Infant wide-field fundus photograph · Phoenix ICON, 100° FOV · 1240x1240px — 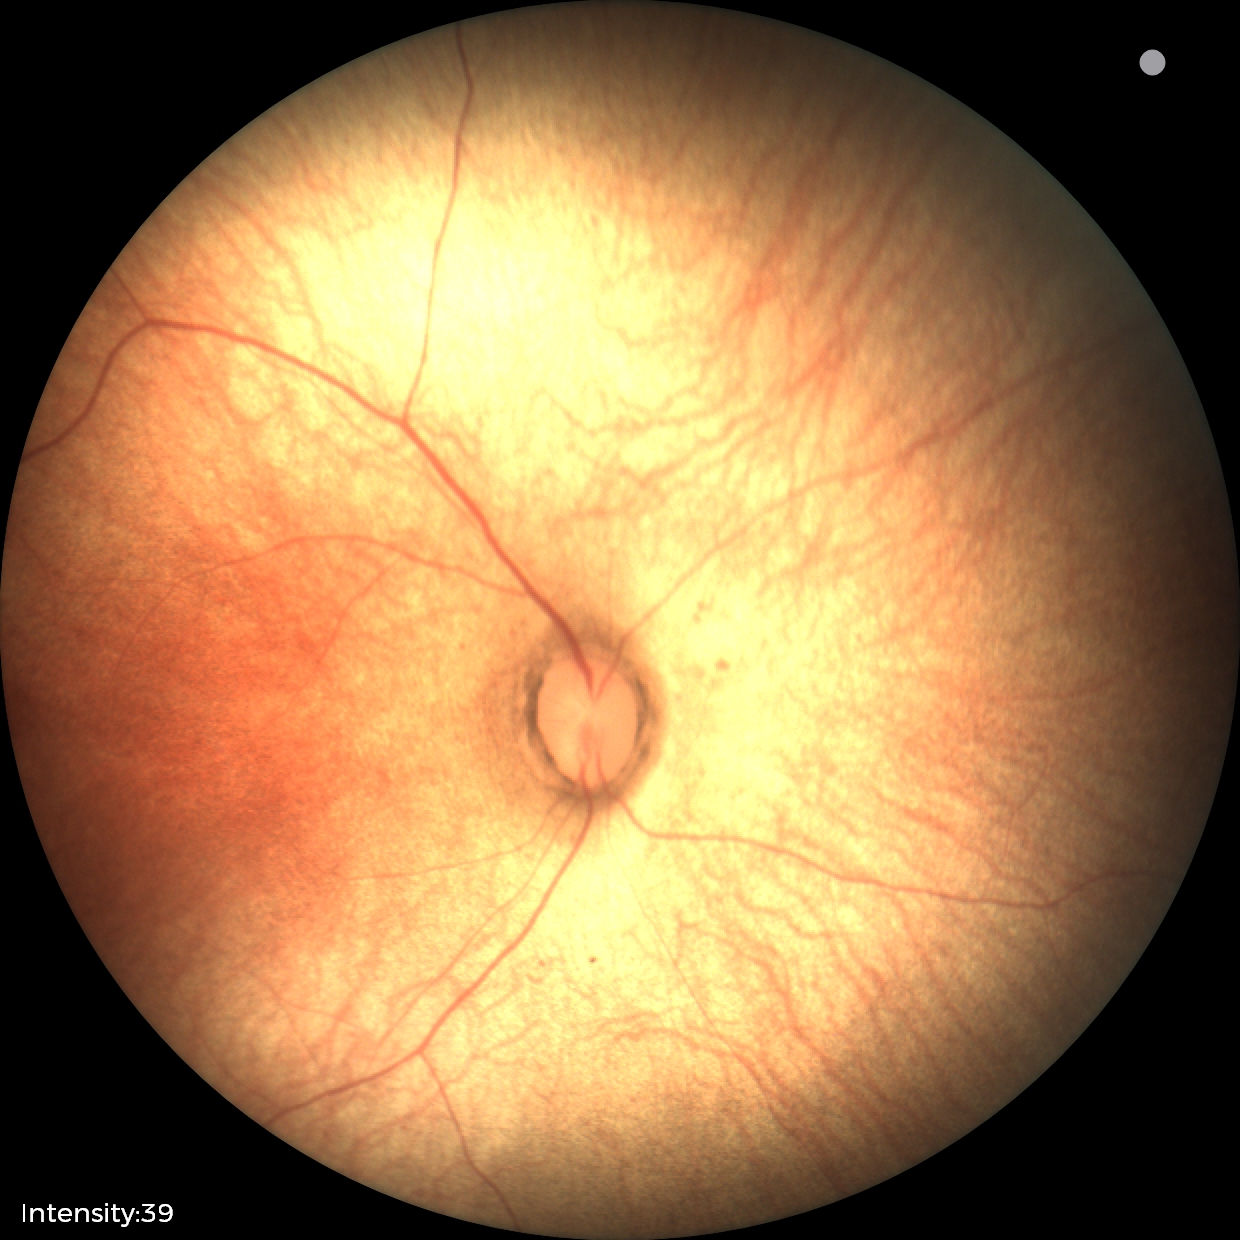
Impression: normal fundus examination.